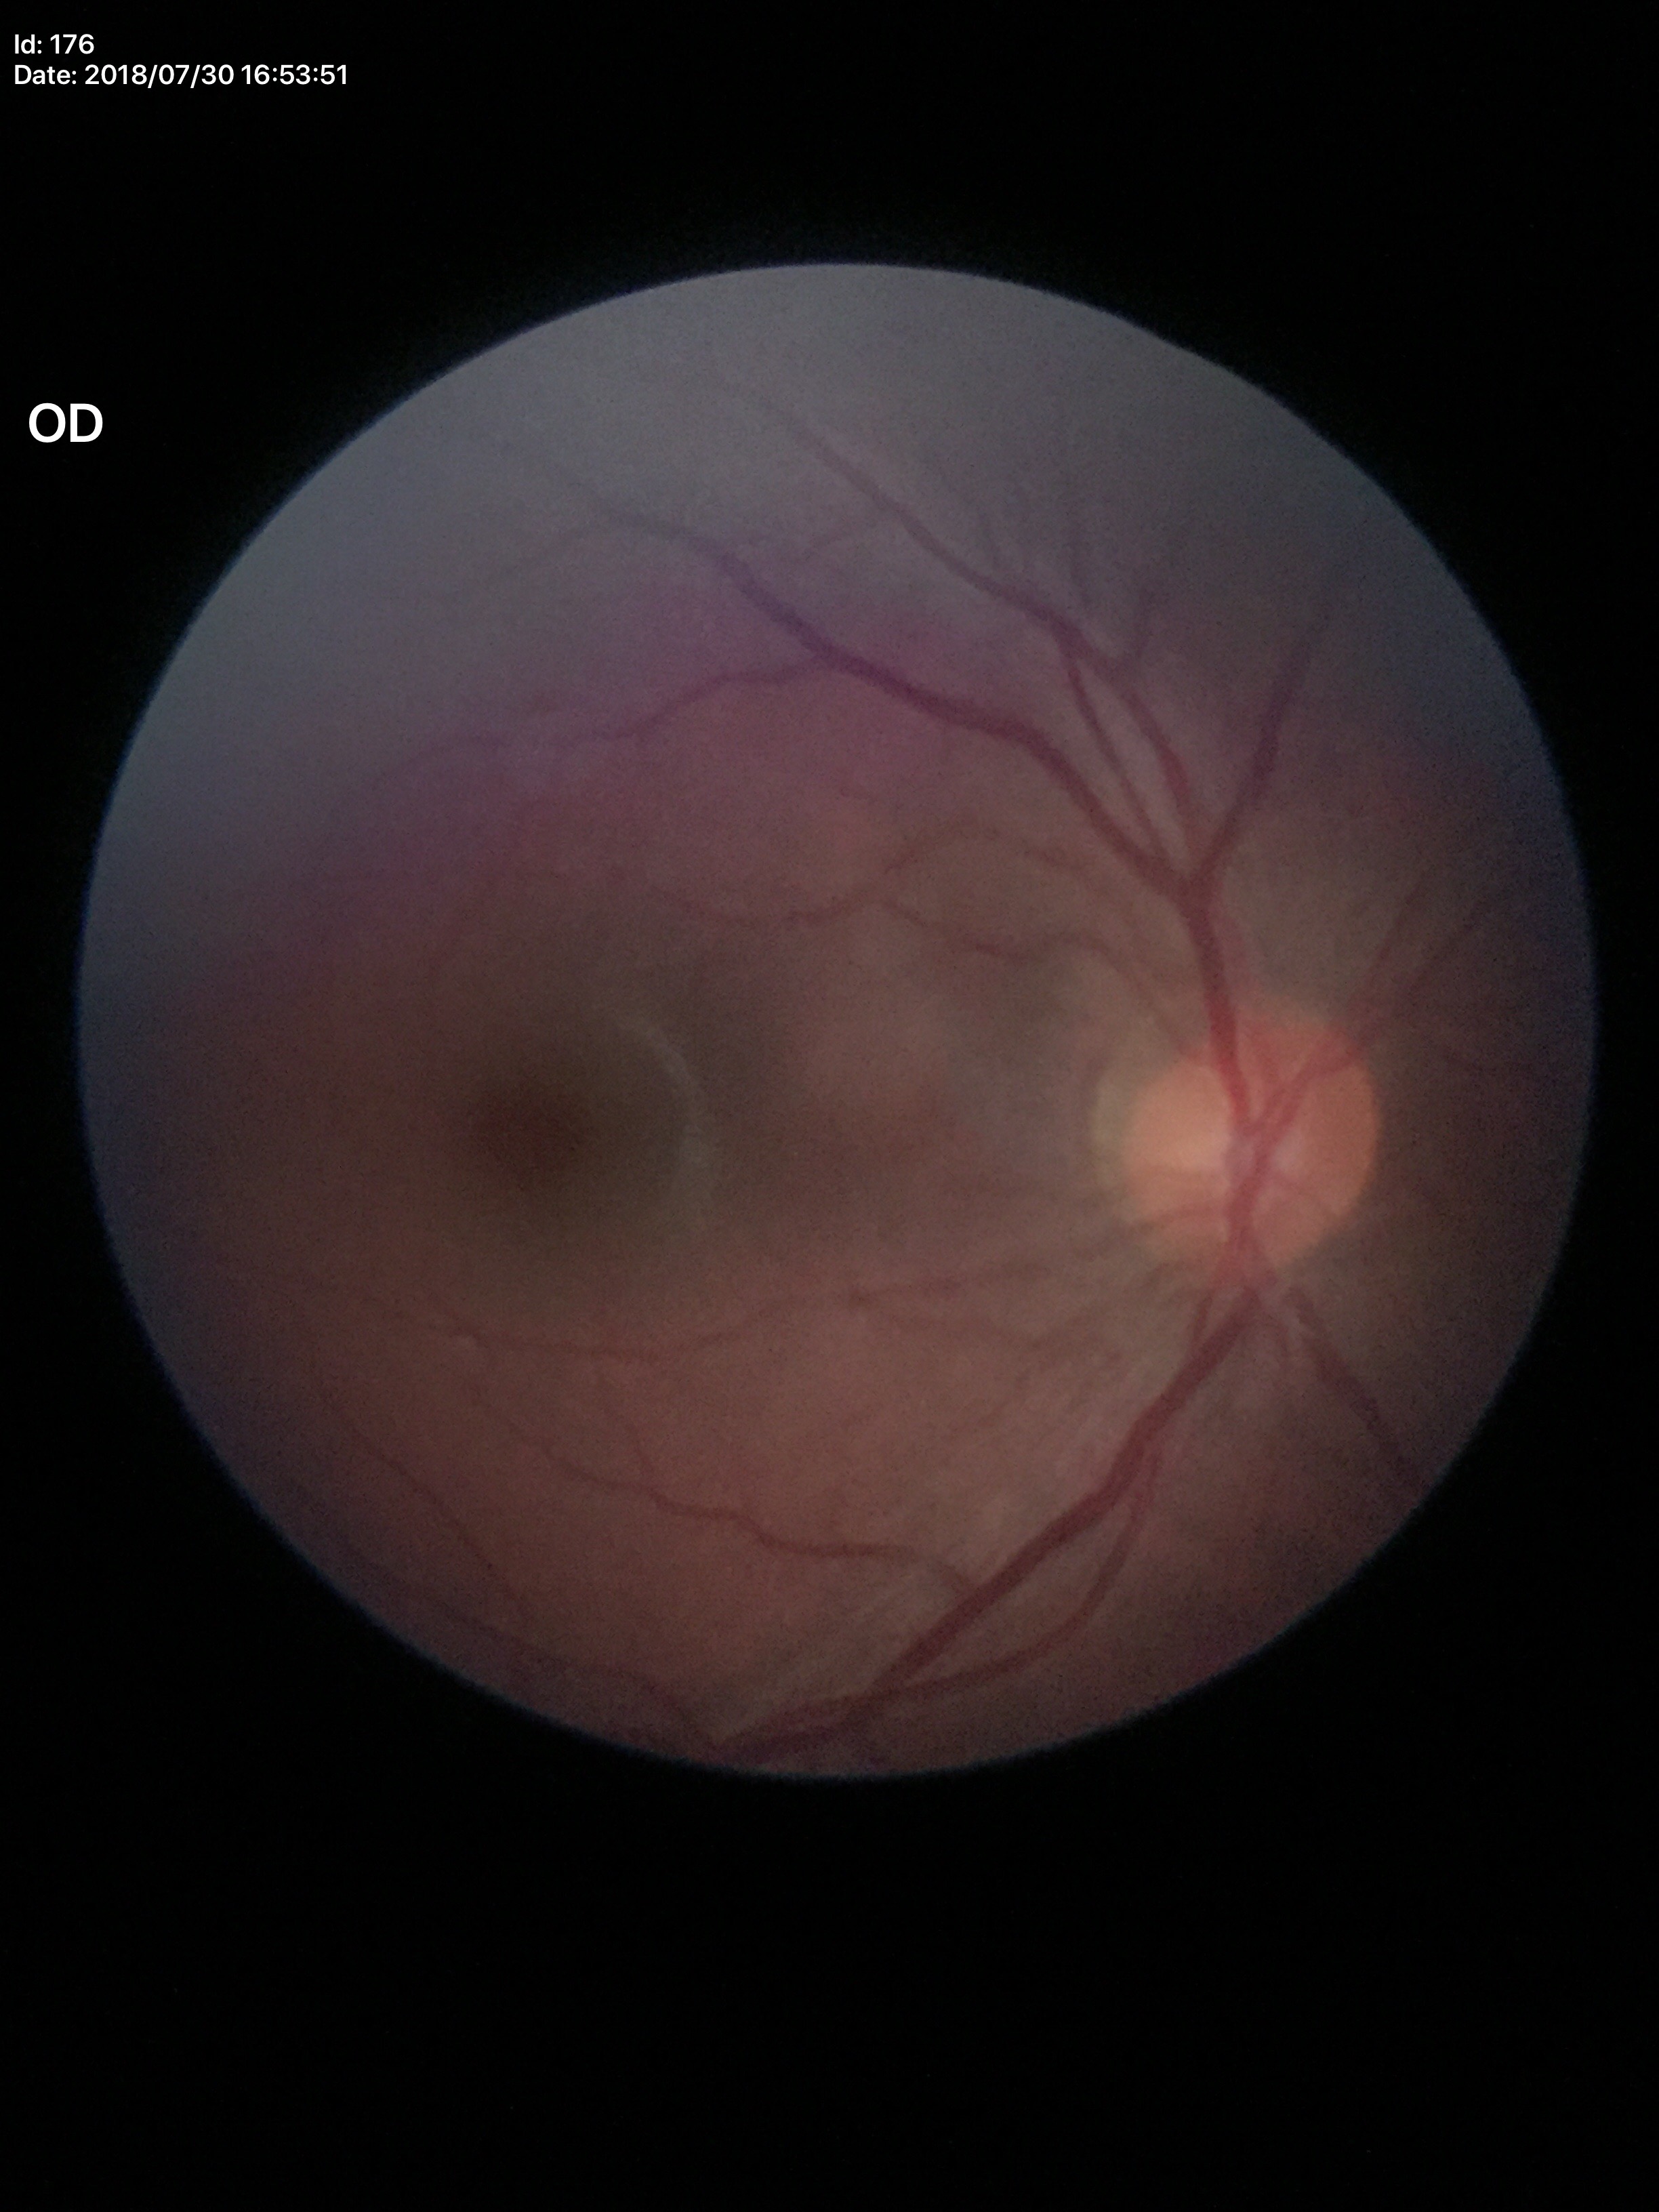 {"glaucoma_decision": "not suspect", "vcdr": "0.44", "hcdr": "0.45", "acdr": "0.20"}